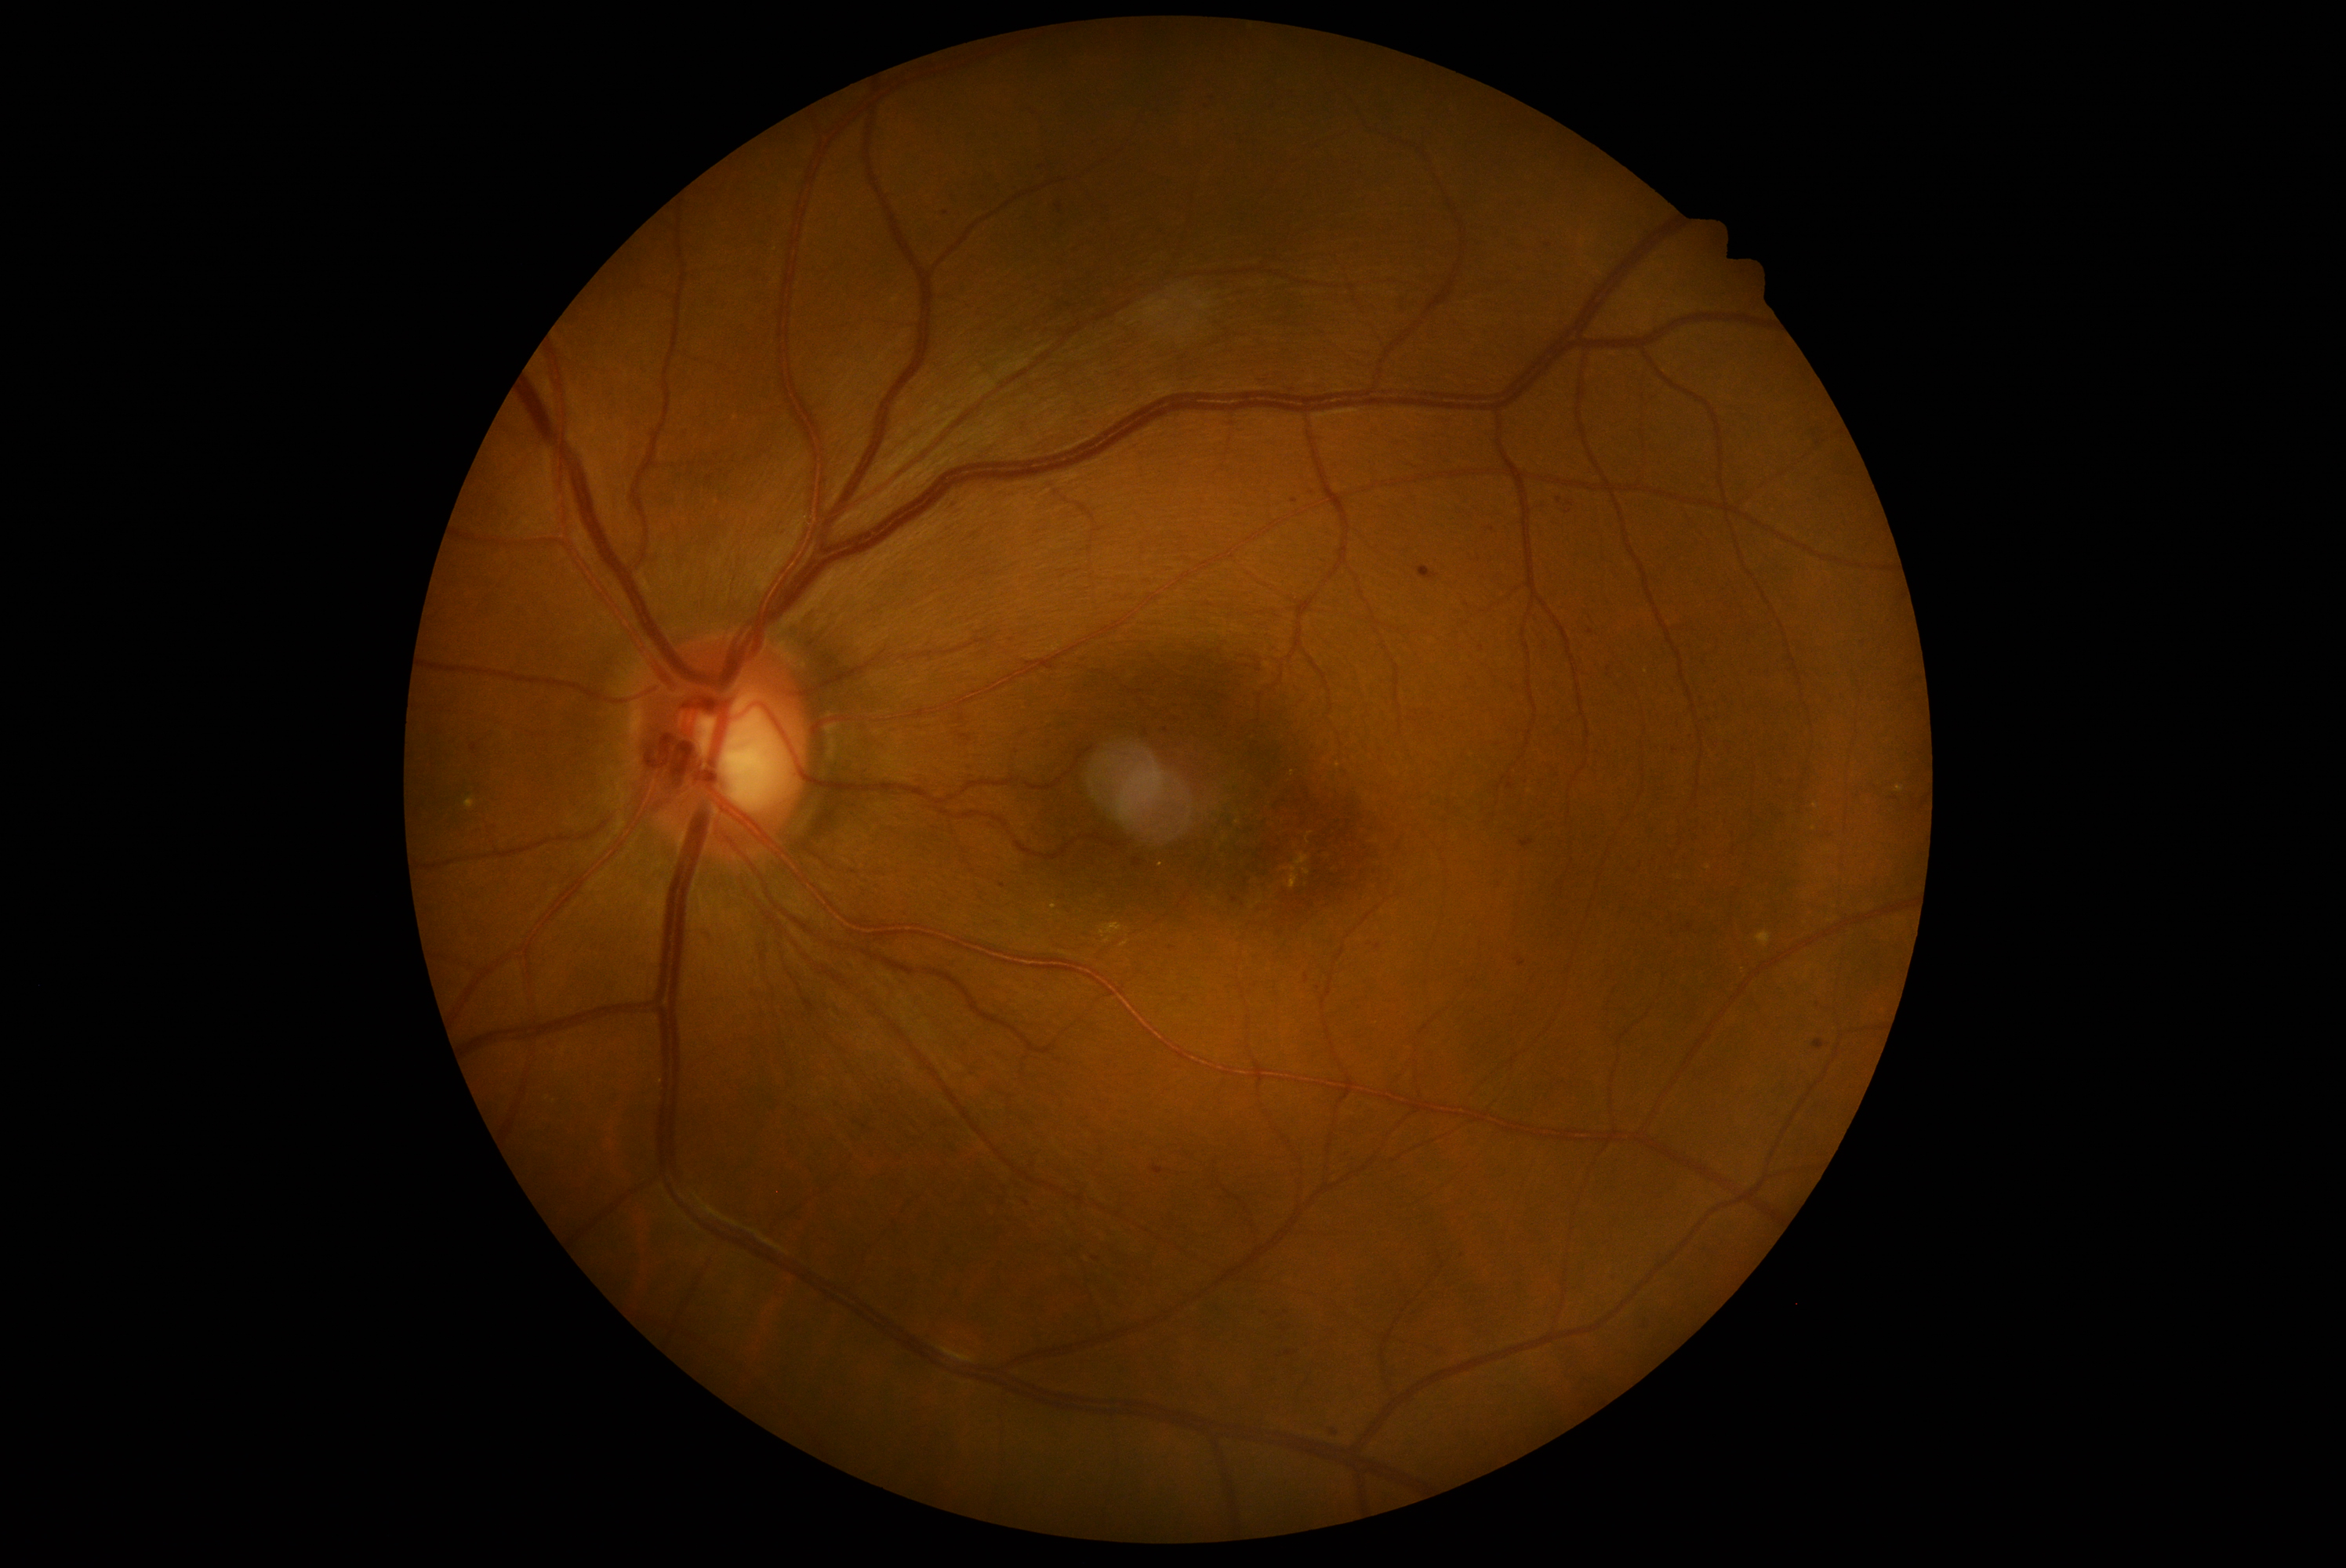
{"partial":true,"dr_grade":2,"dr_grade_name":"moderate NPDR","lesions":{"ma":[[1814,1040,1825,1050],[1304,975,1309,984],[1506,779,1514,789],[1285,1351,1295,1357],[1094,1258,1102,1263]],"ma_small_centers":[[1568,512],[1286,1313],[1311,493],[1027,1203],[1526,781],[1548,246],[1335,1433],[1003,886],[1591,633],[1609,669],[1711,718]]}}